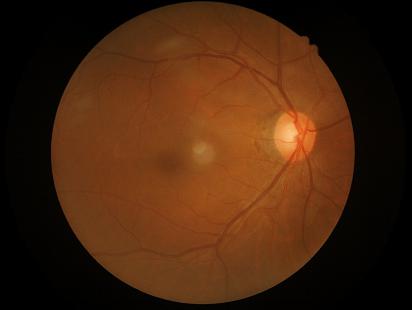

Overall quality = adequate
Contrast = good
Focus = good